Posterior pole photograph; 45-degree field of view; nonmydriatic fundus photograph; NIDEK AFC-230 — 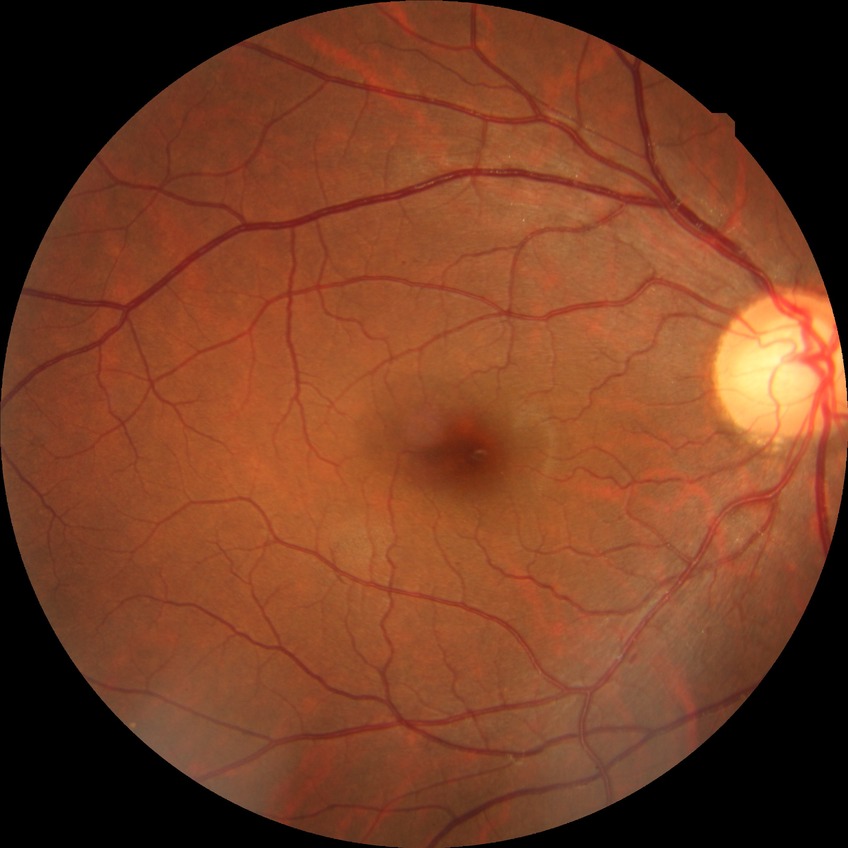 DR class: non-proliferative diabetic retinopathy
diabetic retinopathy (DR): SDR (simple diabetic retinopathy)